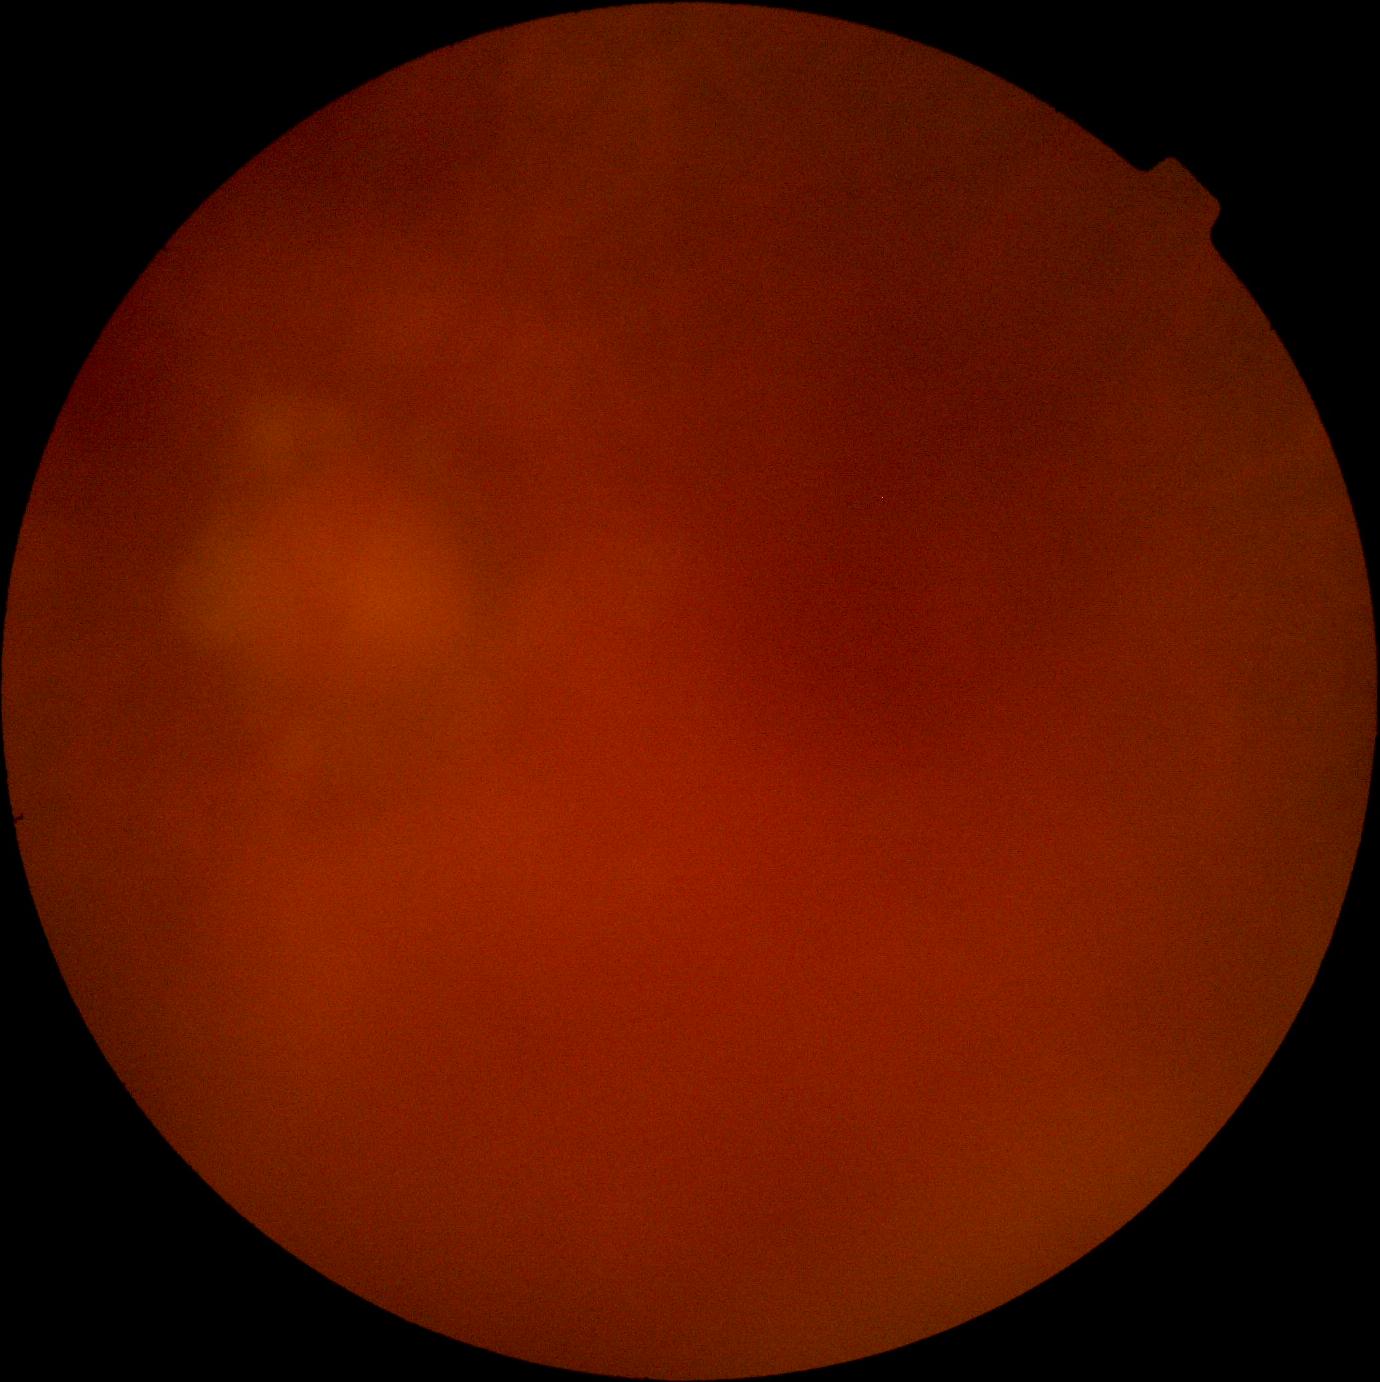

diabetic retinopathy (DR): ungradable; image quality: insufficient.